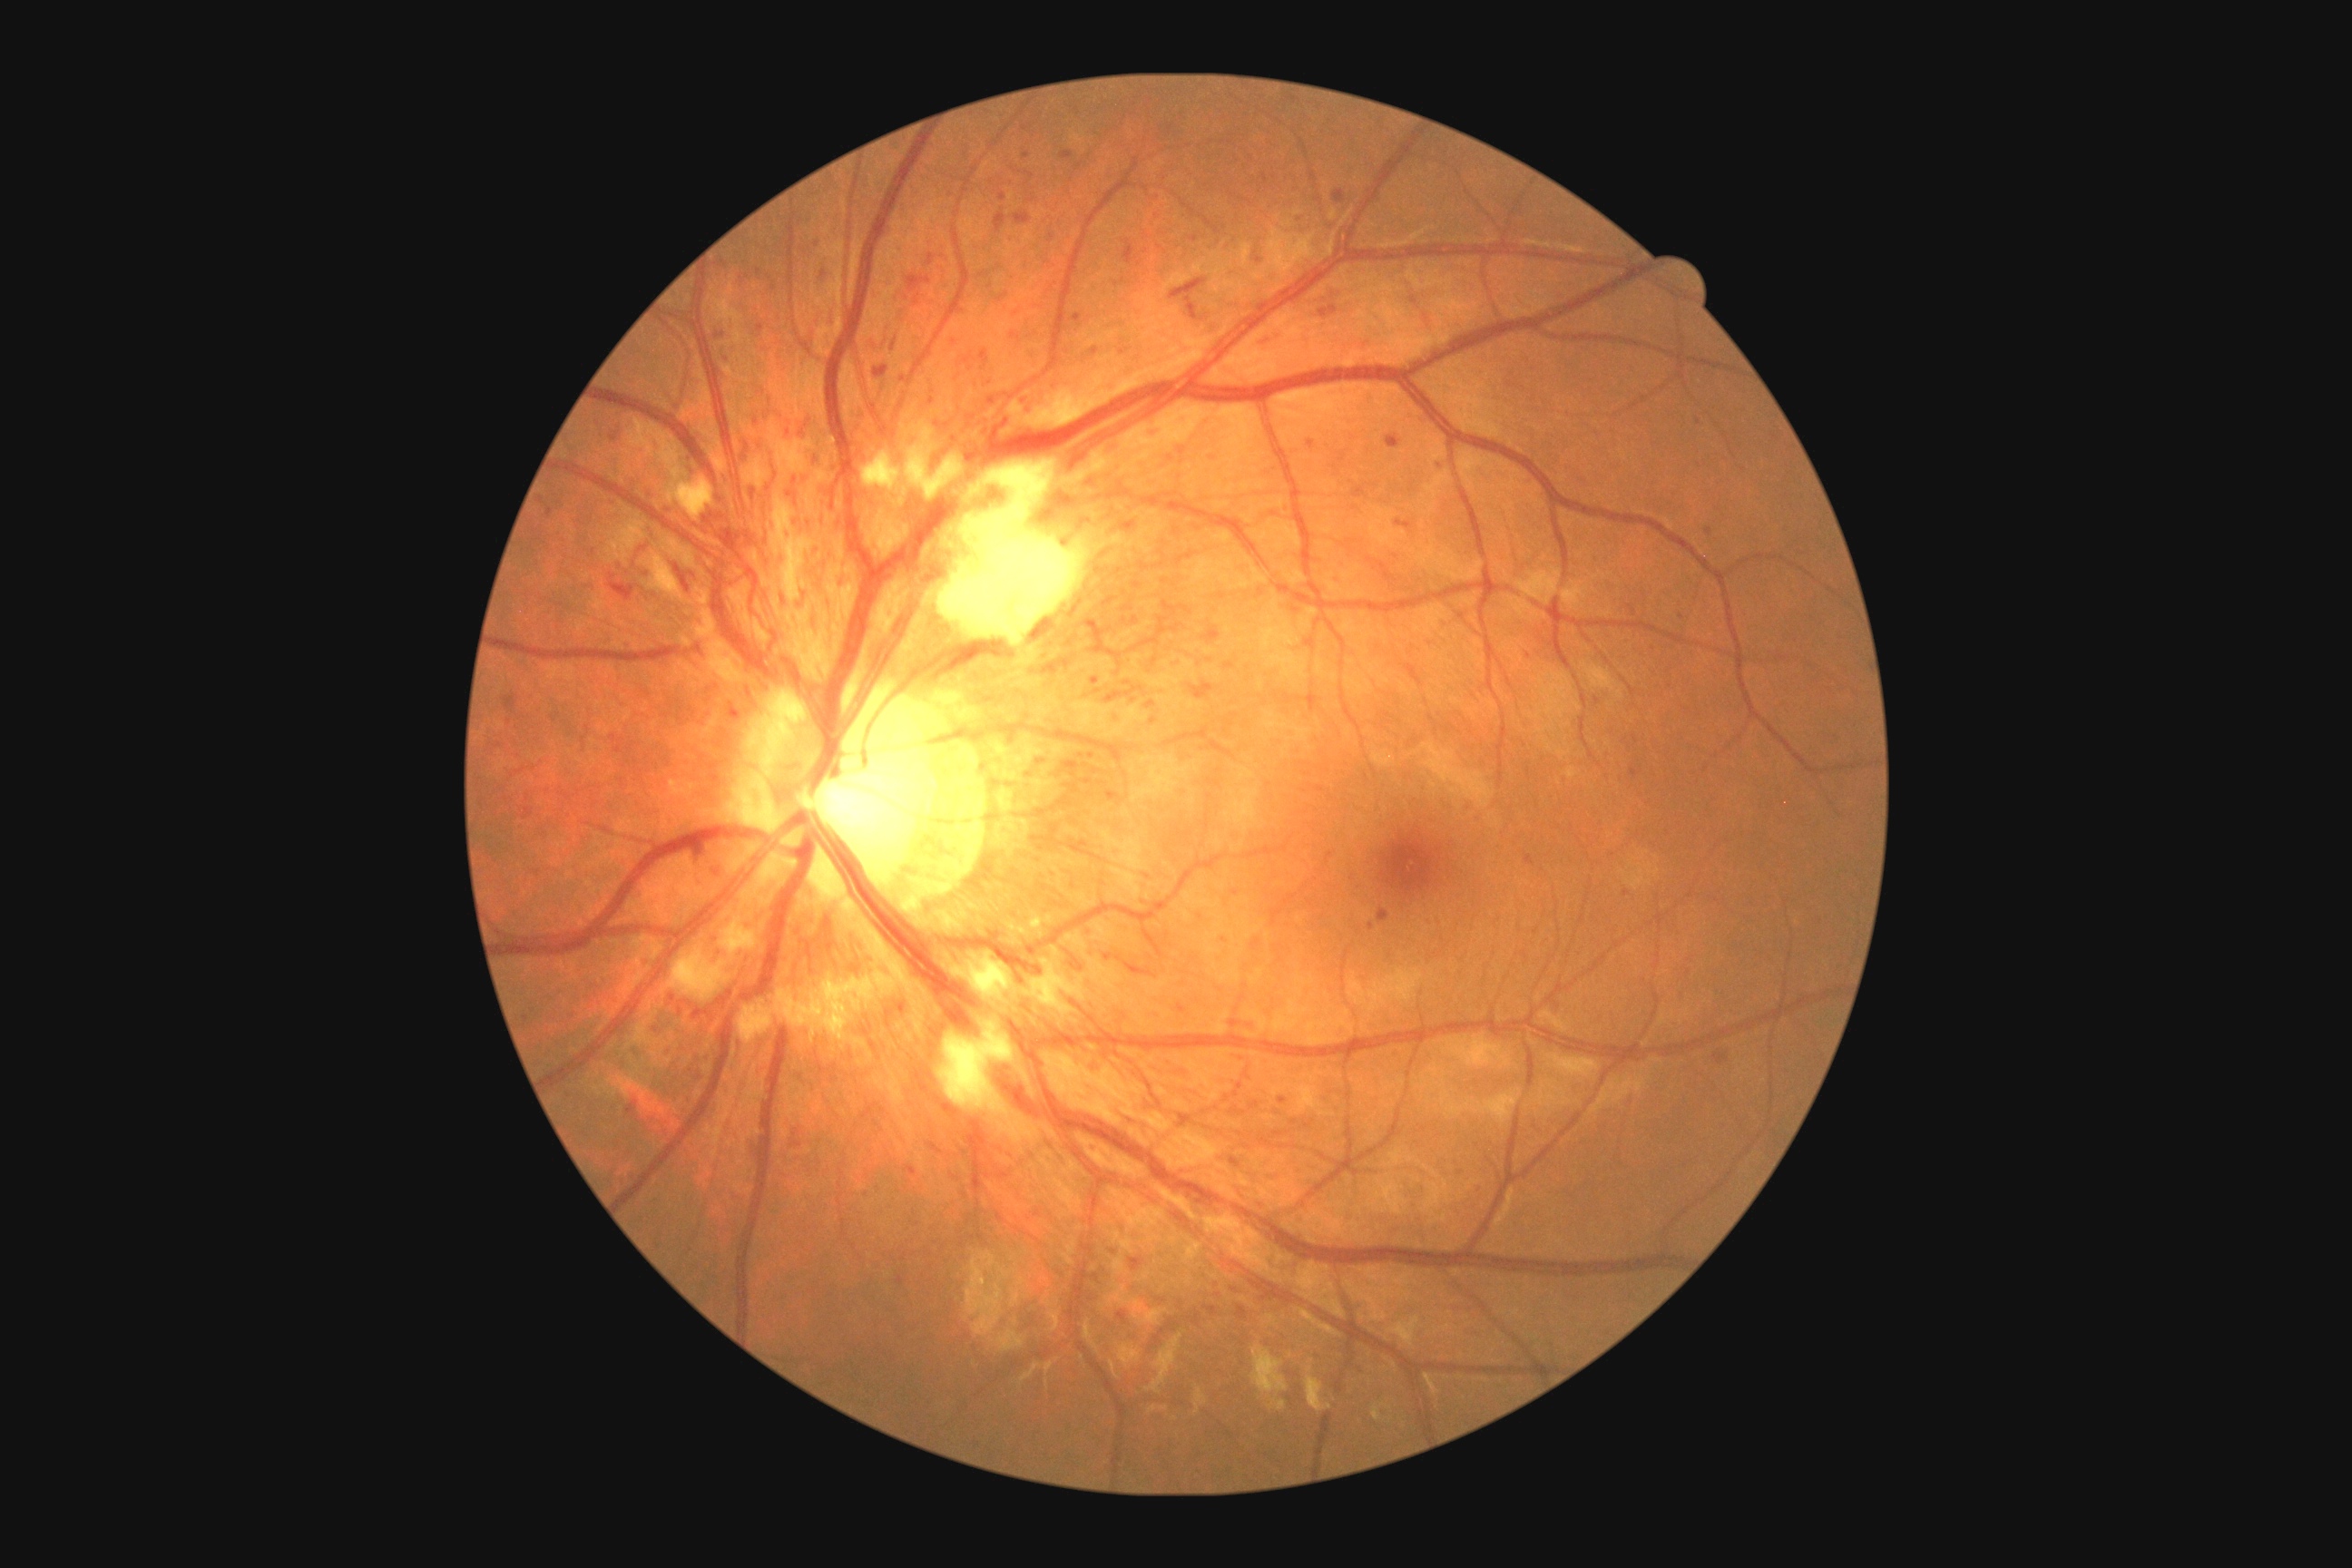

Diabetic retinopathy: severe non-proliferative diabetic retinopathy (grade 3).